Modified Davis classification.
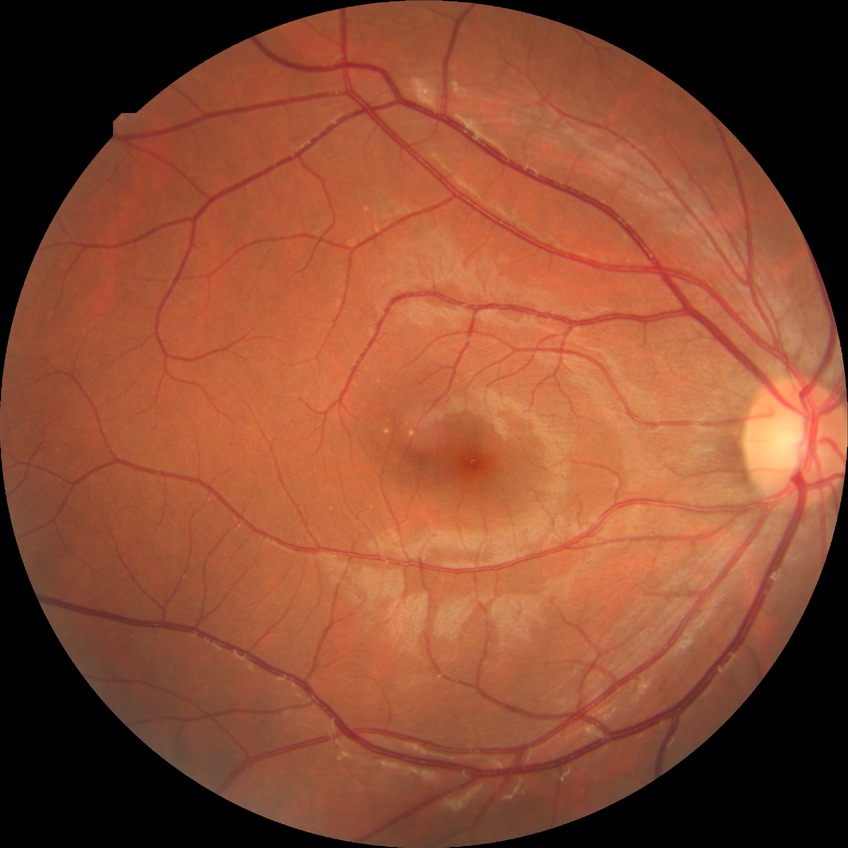
Diabetic retinopathy (DR): no diabetic retinopathy (NDR).